Portable fundus camera image · 60° FOV: 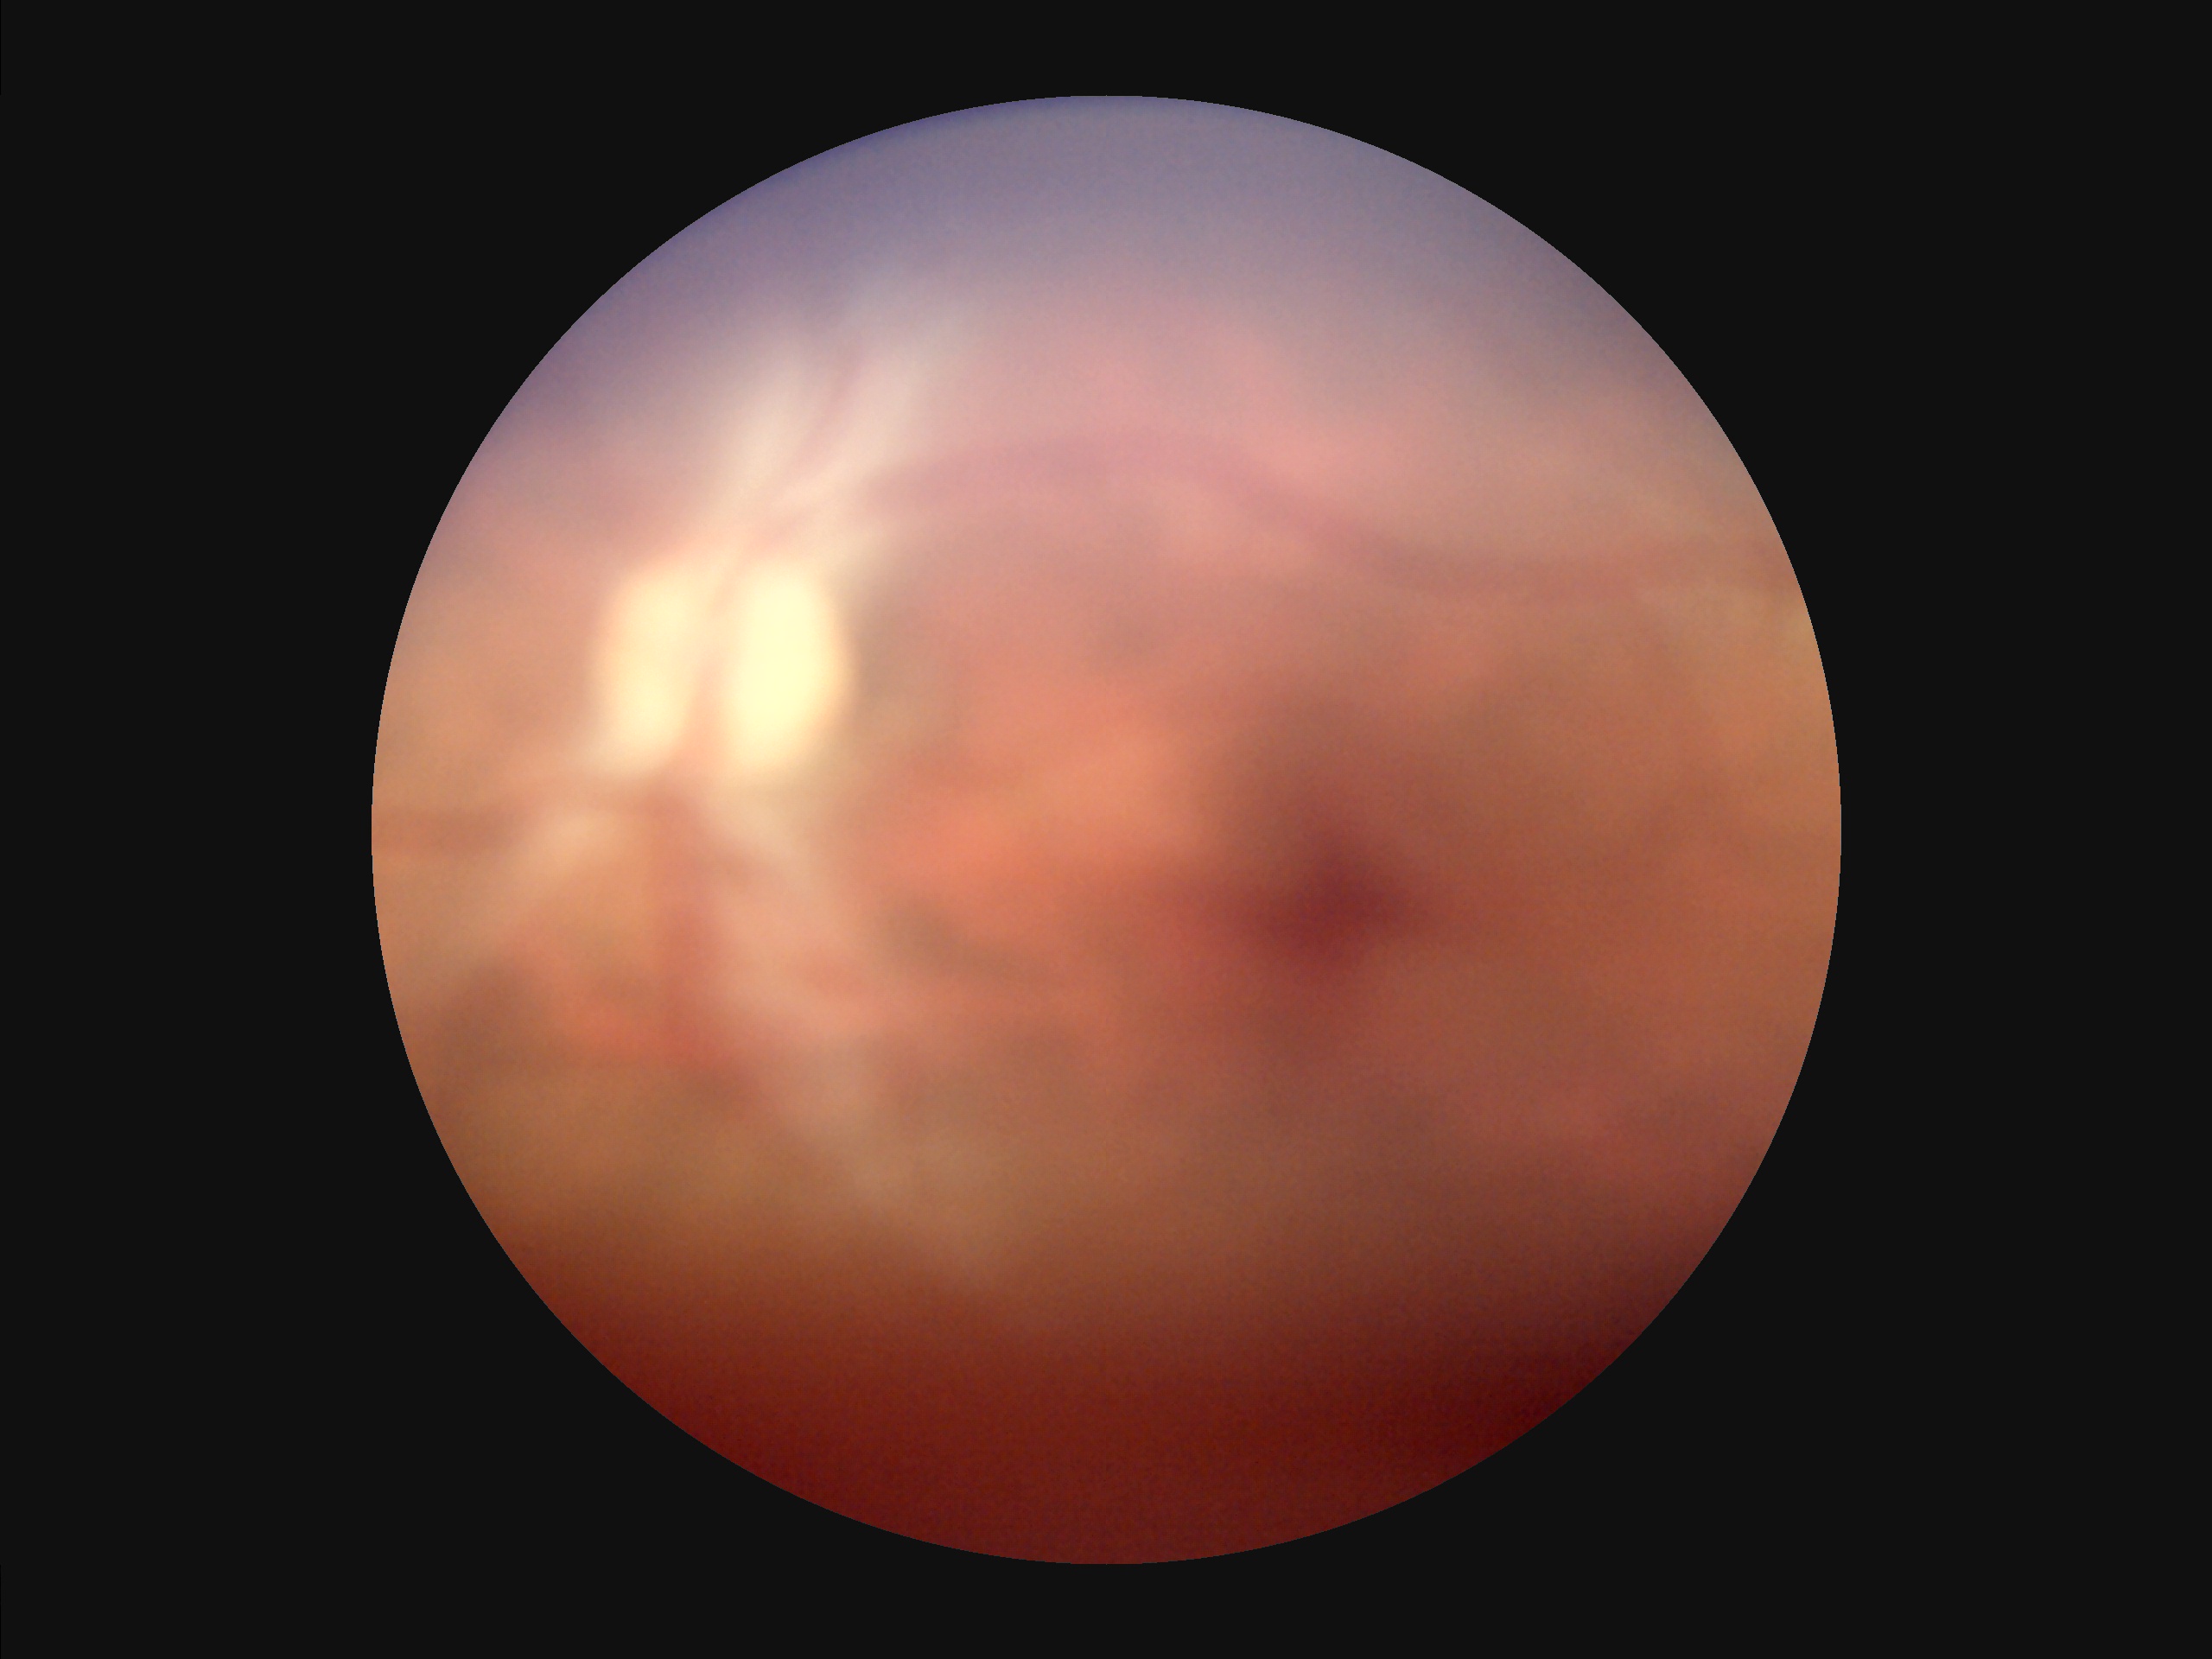

Illumination: poor | Overall quality: suboptimal | Contrast: poor | Clarity: reduced.